Wide-field fundus photograph of an infant
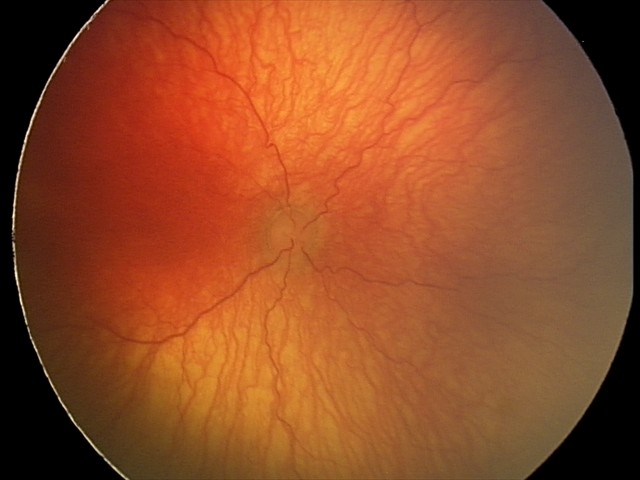
Examination diagnosed as A-ROP (aggressive ROP).